2089x1764. Color fundus photograph
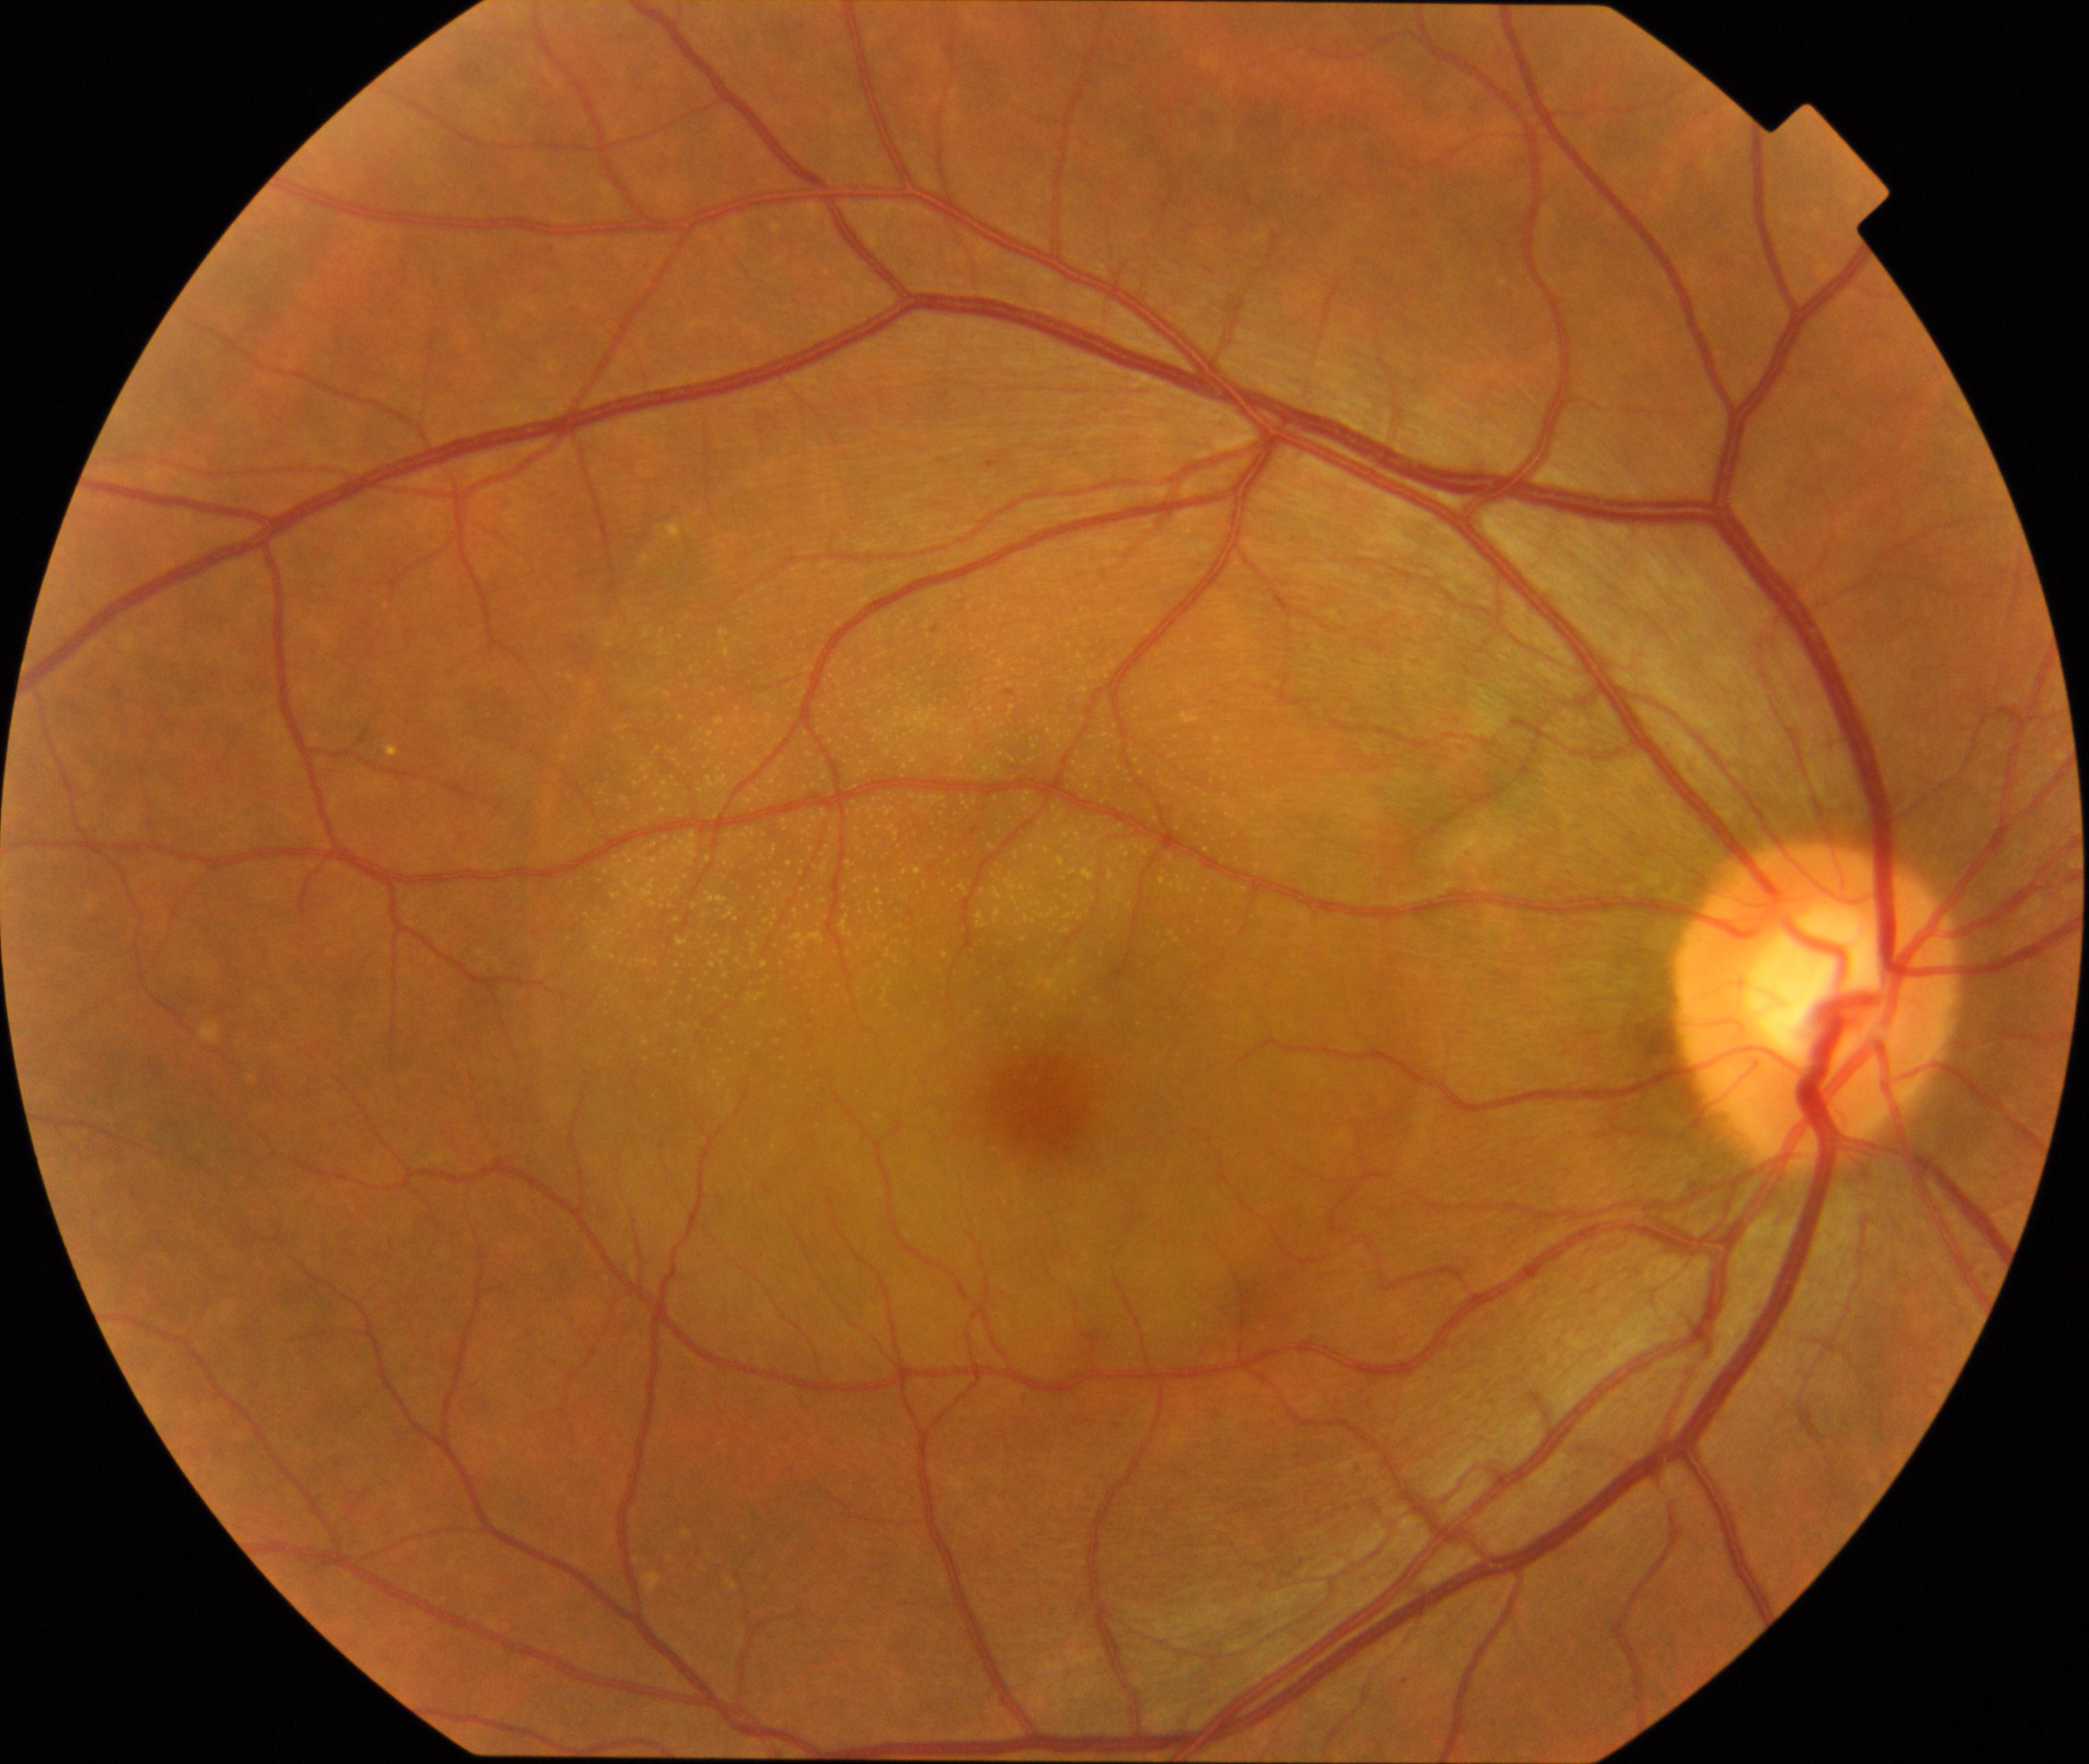

The image shows central serous chorioretinopathy (CSCR). Features include round or oval retinal elevation with clear or turbid fluid underneath, sometimes with depigmented retinal pigment epithelium (RPE) foci or small patches of RPE atrophy or hyperplasia.